Nonmydriatic fundus photograph, modified Davis classification:
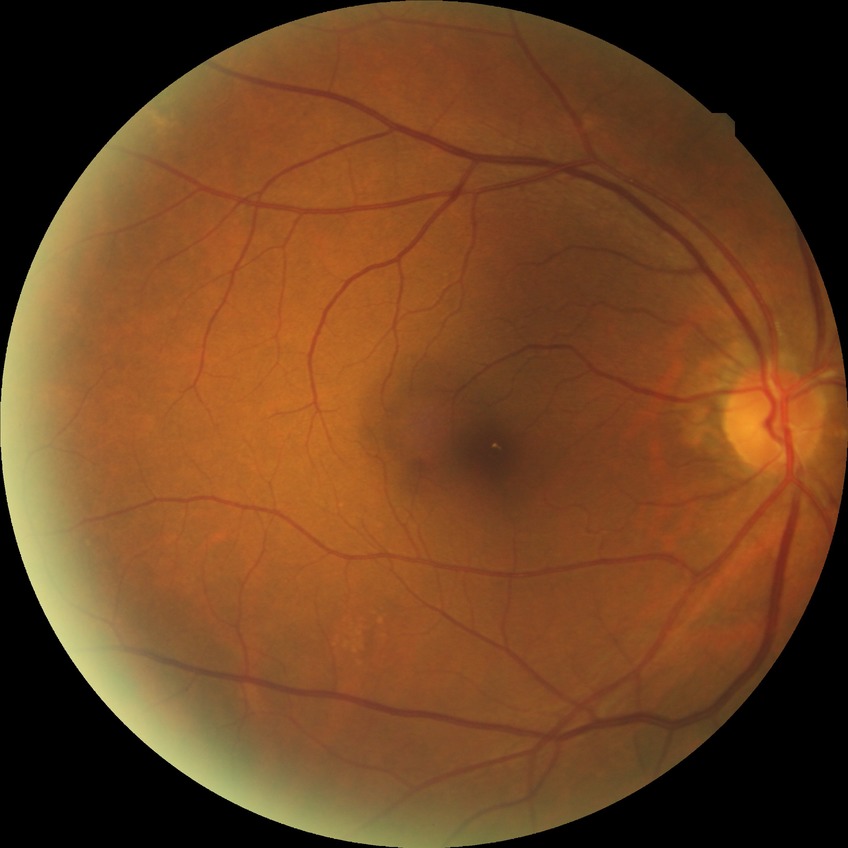 Diabetic retinopathy (DR) is NDR (no diabetic retinopathy).